NIDEK AFC-230, modified Davis grading, retinal fundus photograph
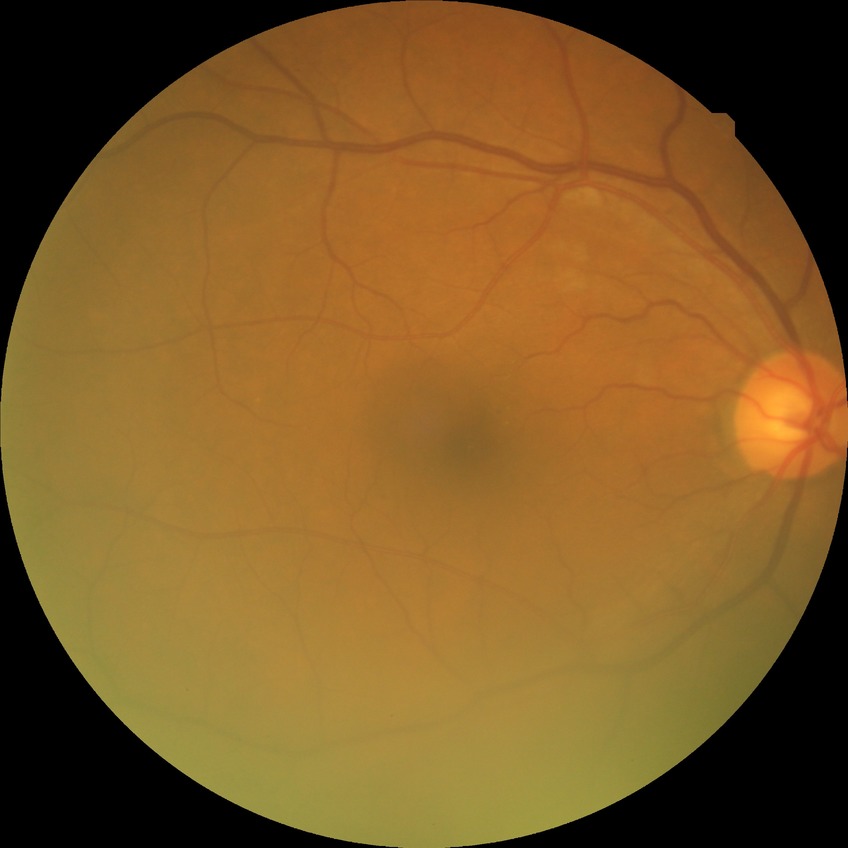 Modified Davis classification is no diabetic retinopathy.